45° field of view, image size 2212x1672: 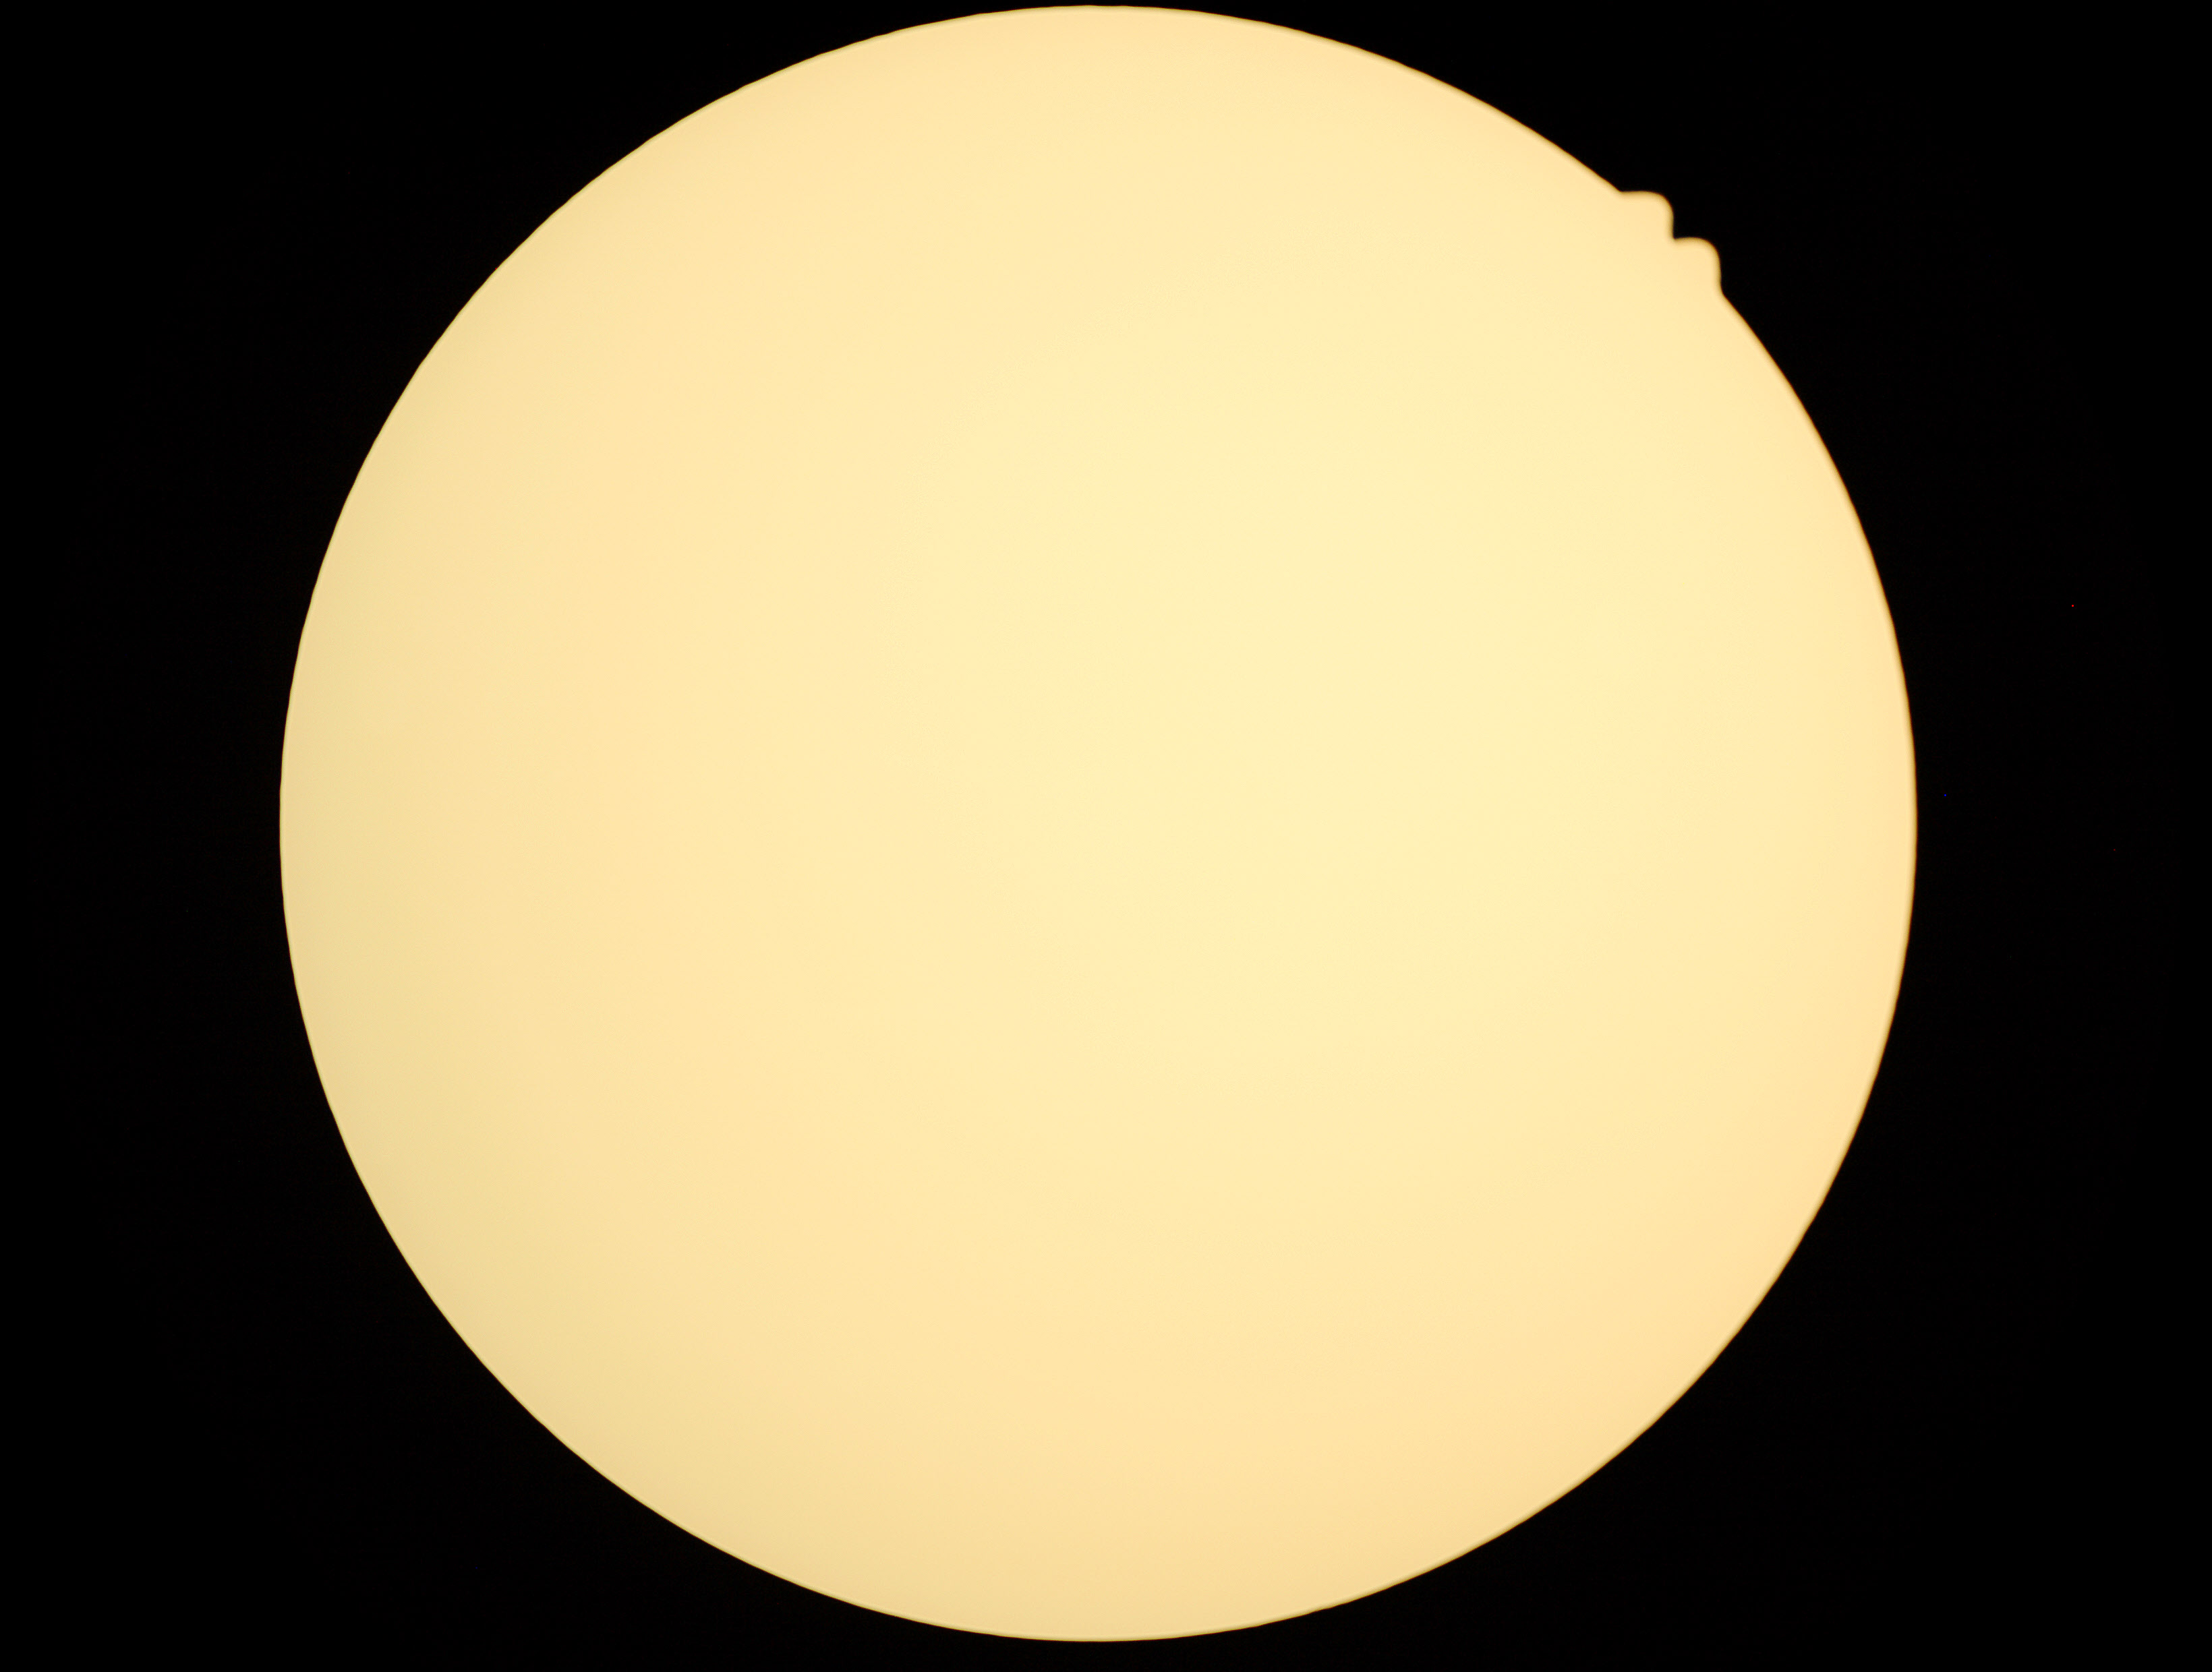
The image cannot be graded for diabetic retinopathy. DR grade: ungradable.